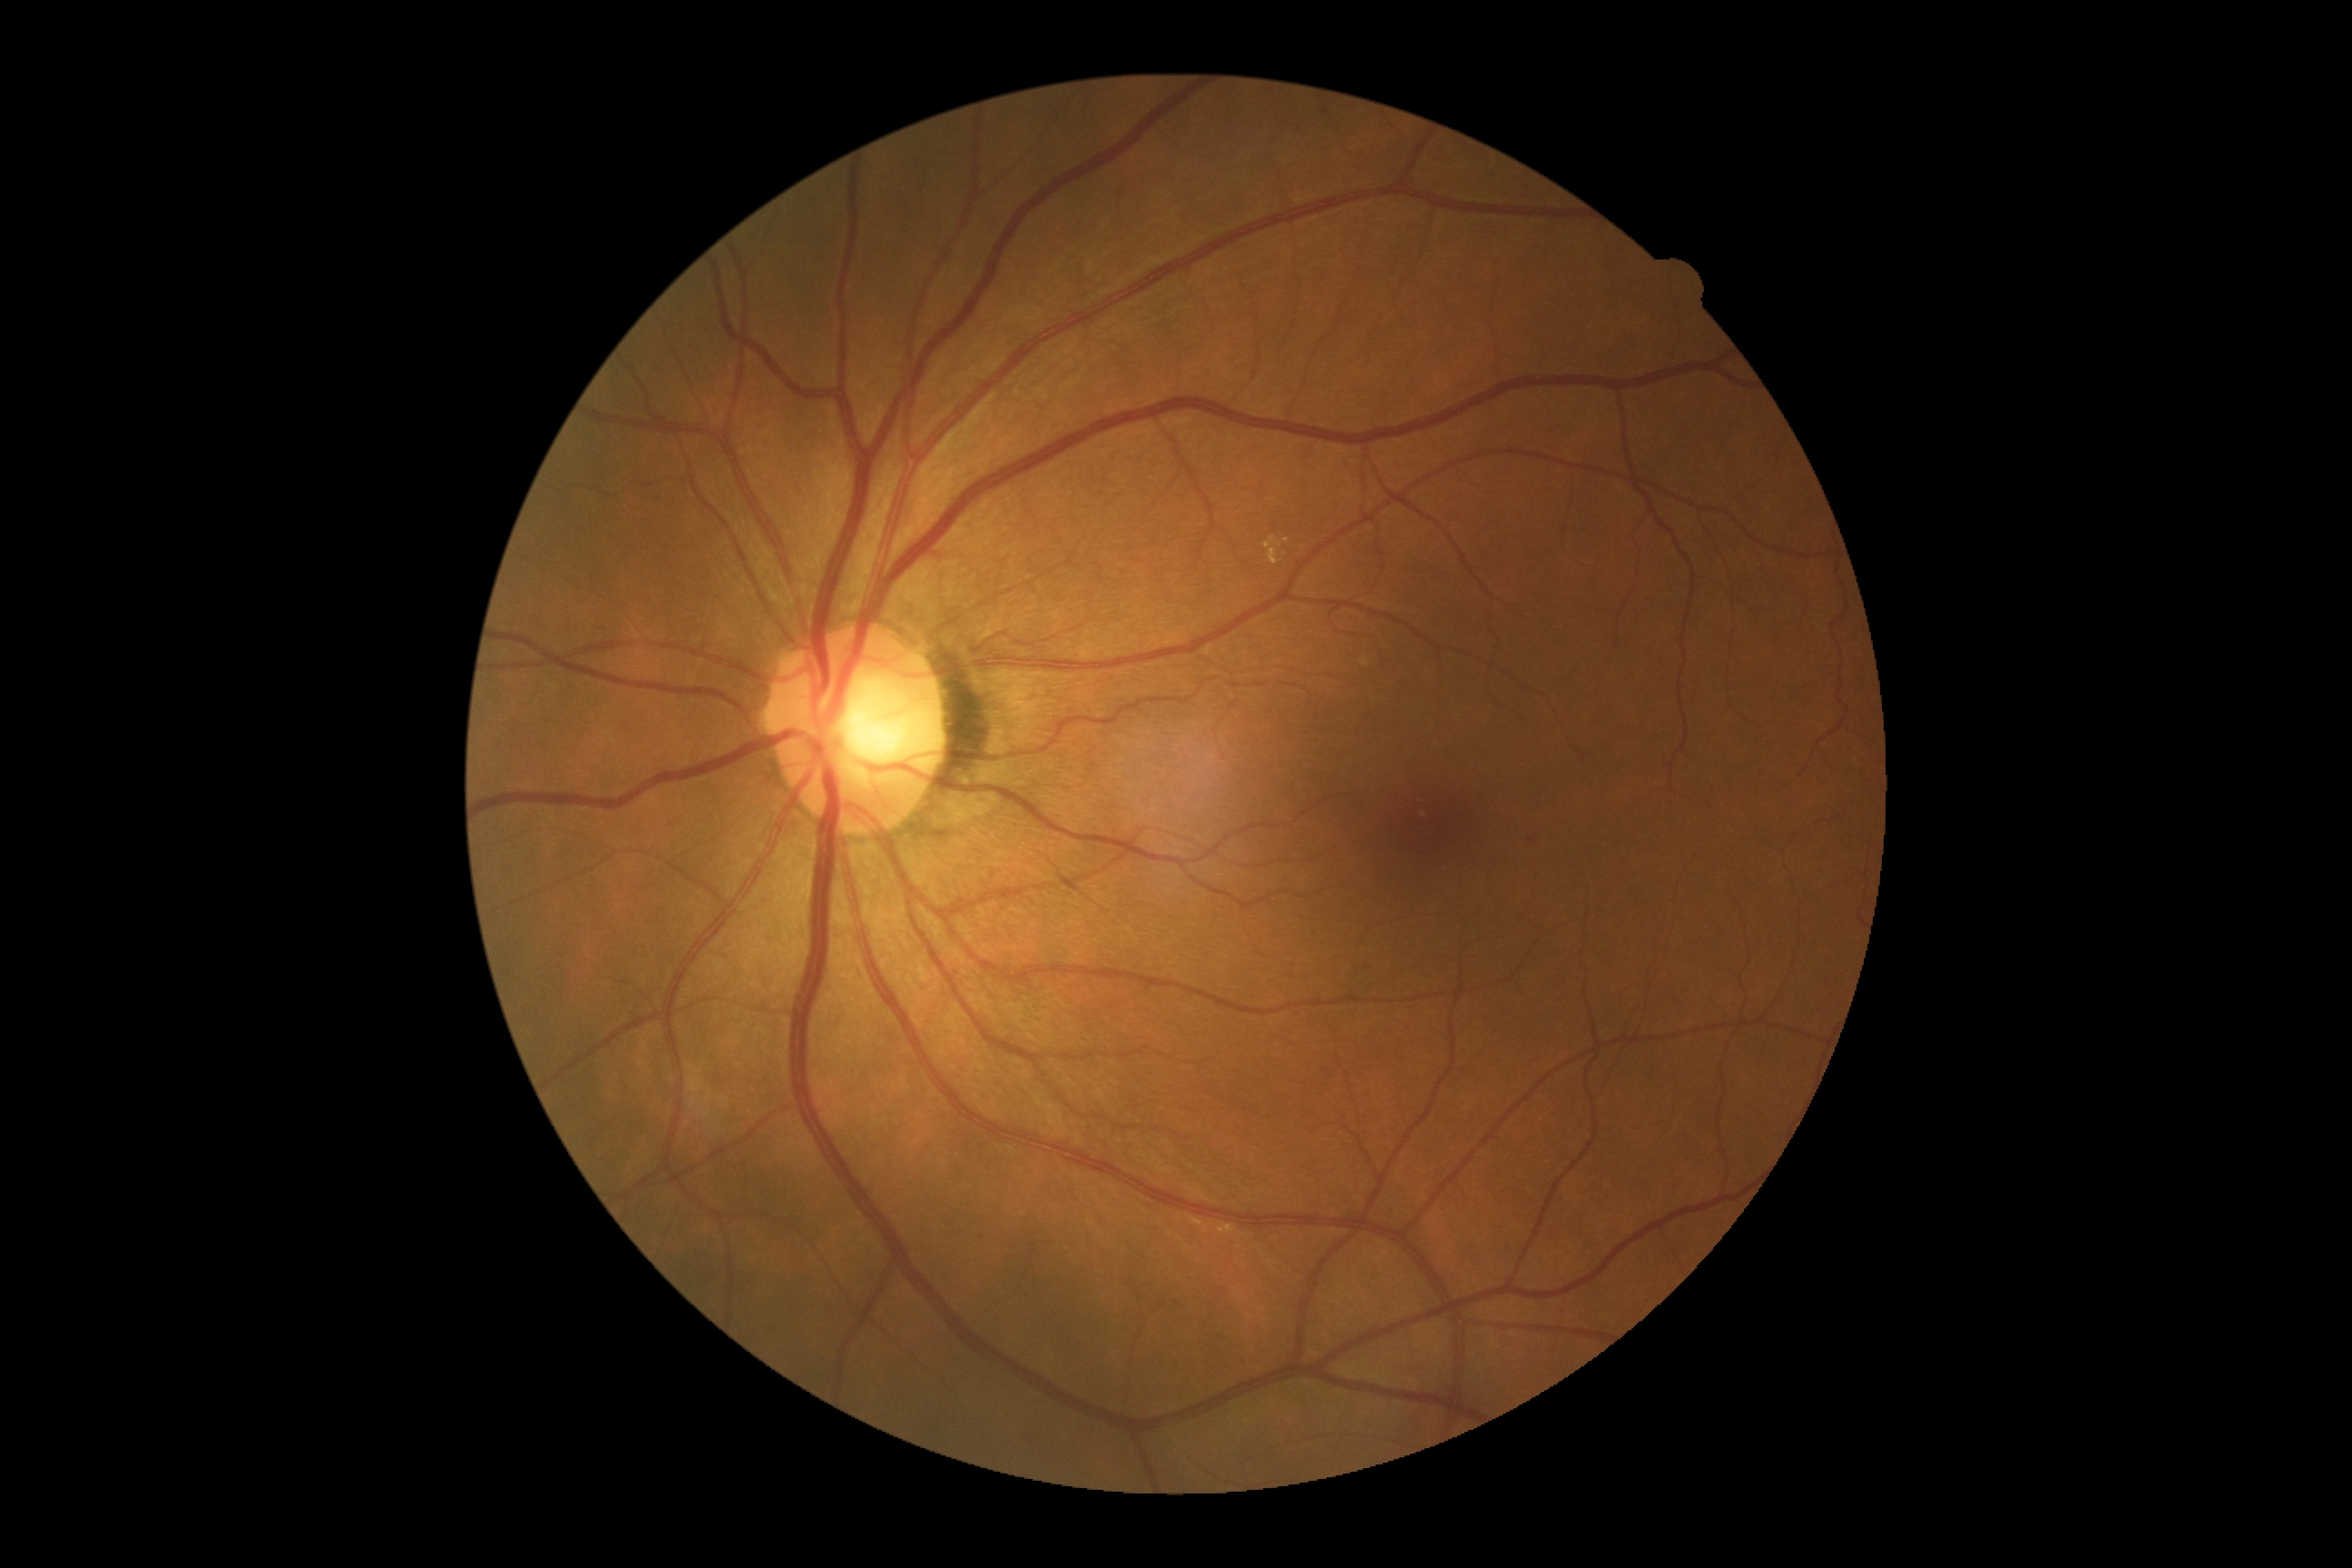
* diabetic retinopathy grade: 2 — more than just microaneurysms but less than severe NPDR